45° field of view. Without pupil dilation: 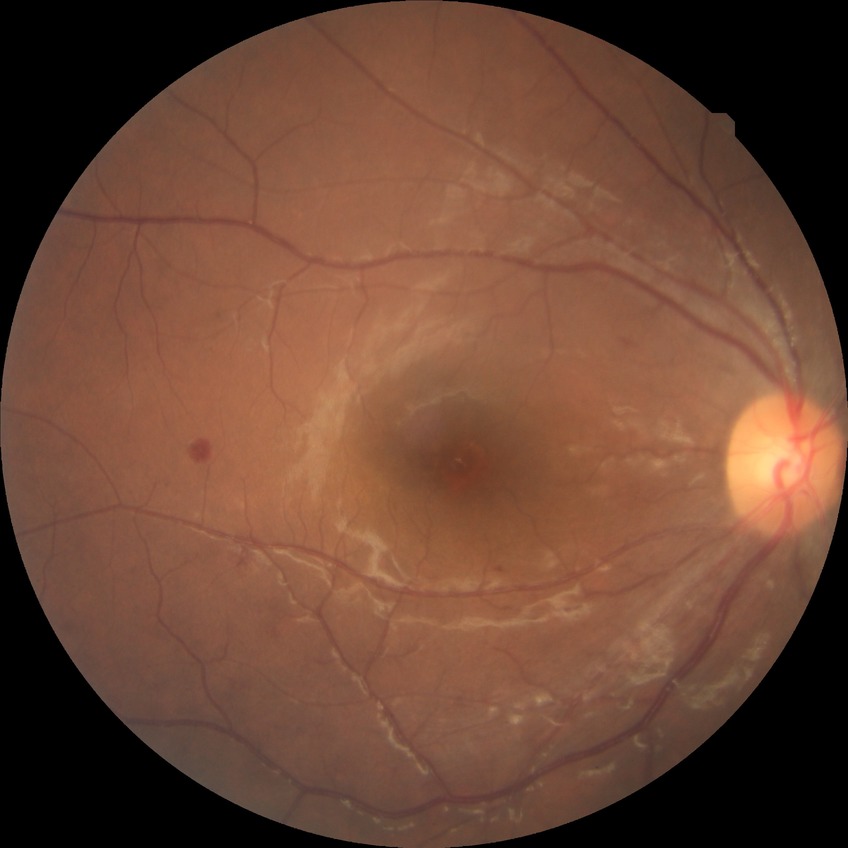

Findings:
* diabetic retinopathy (DR): NDR (no diabetic retinopathy)